Fundus photo · 45° FOV · 2352 by 1568 pixels: 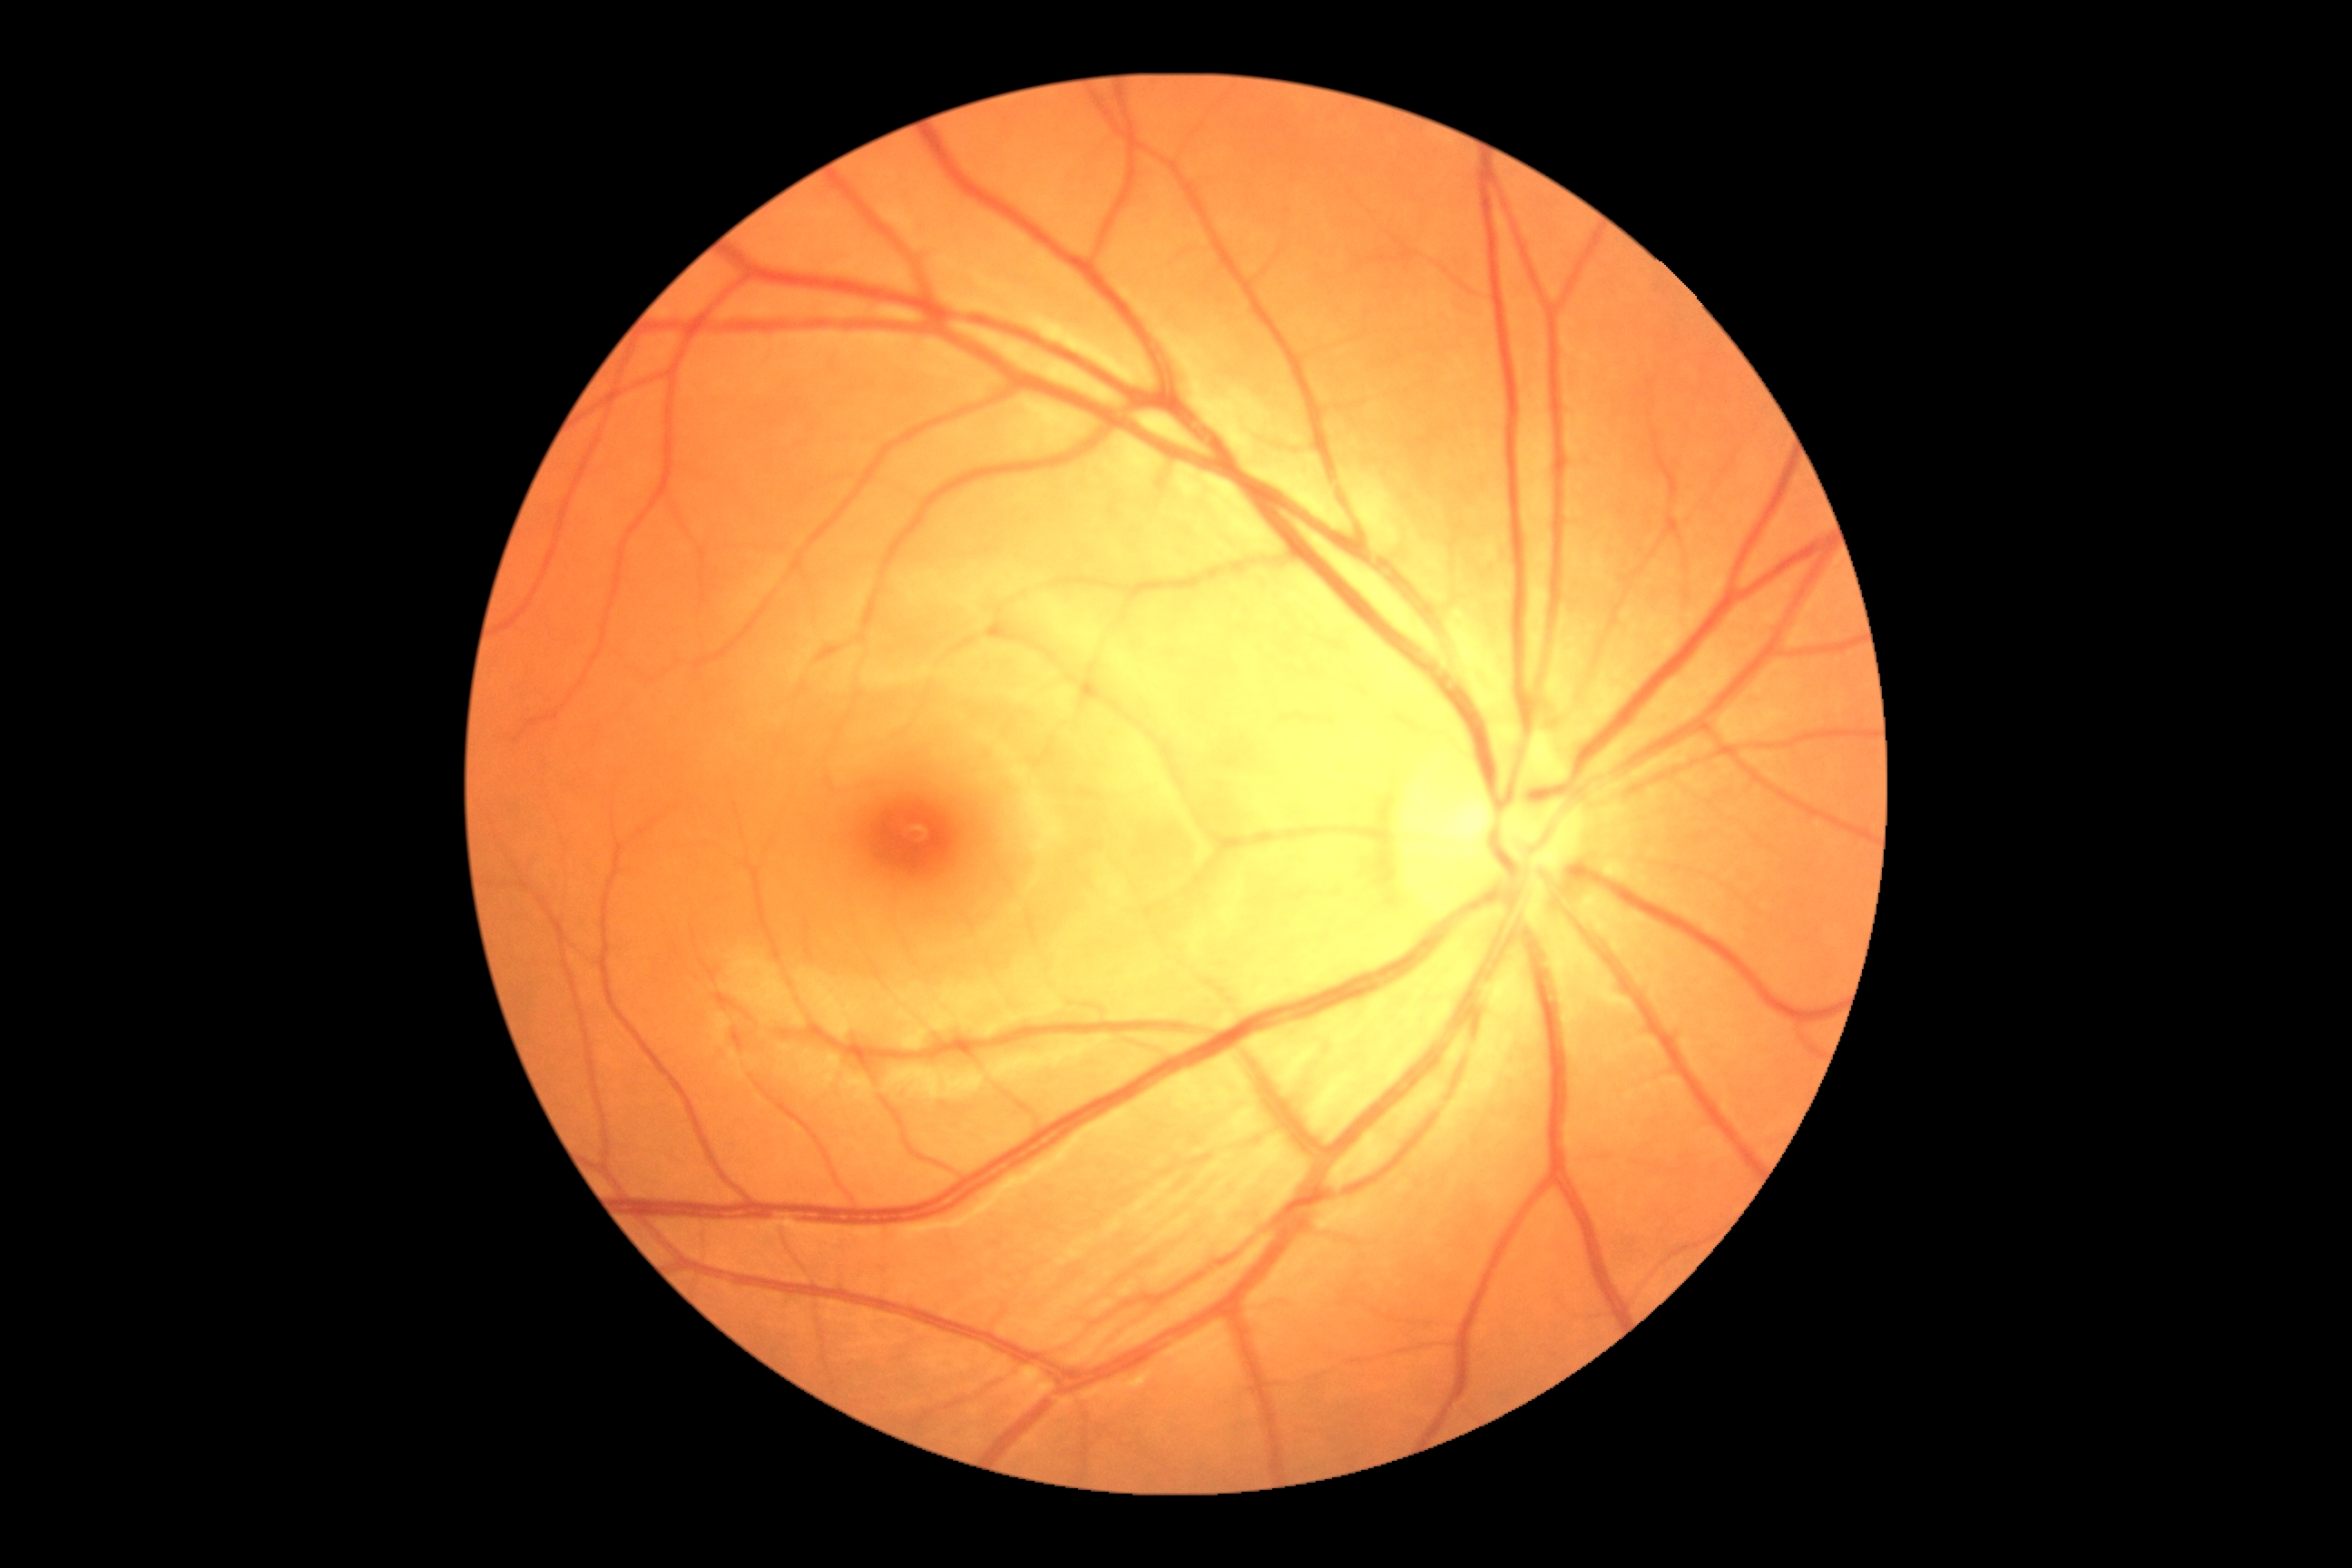 DR: grade 0 (no apparent retinopathy).